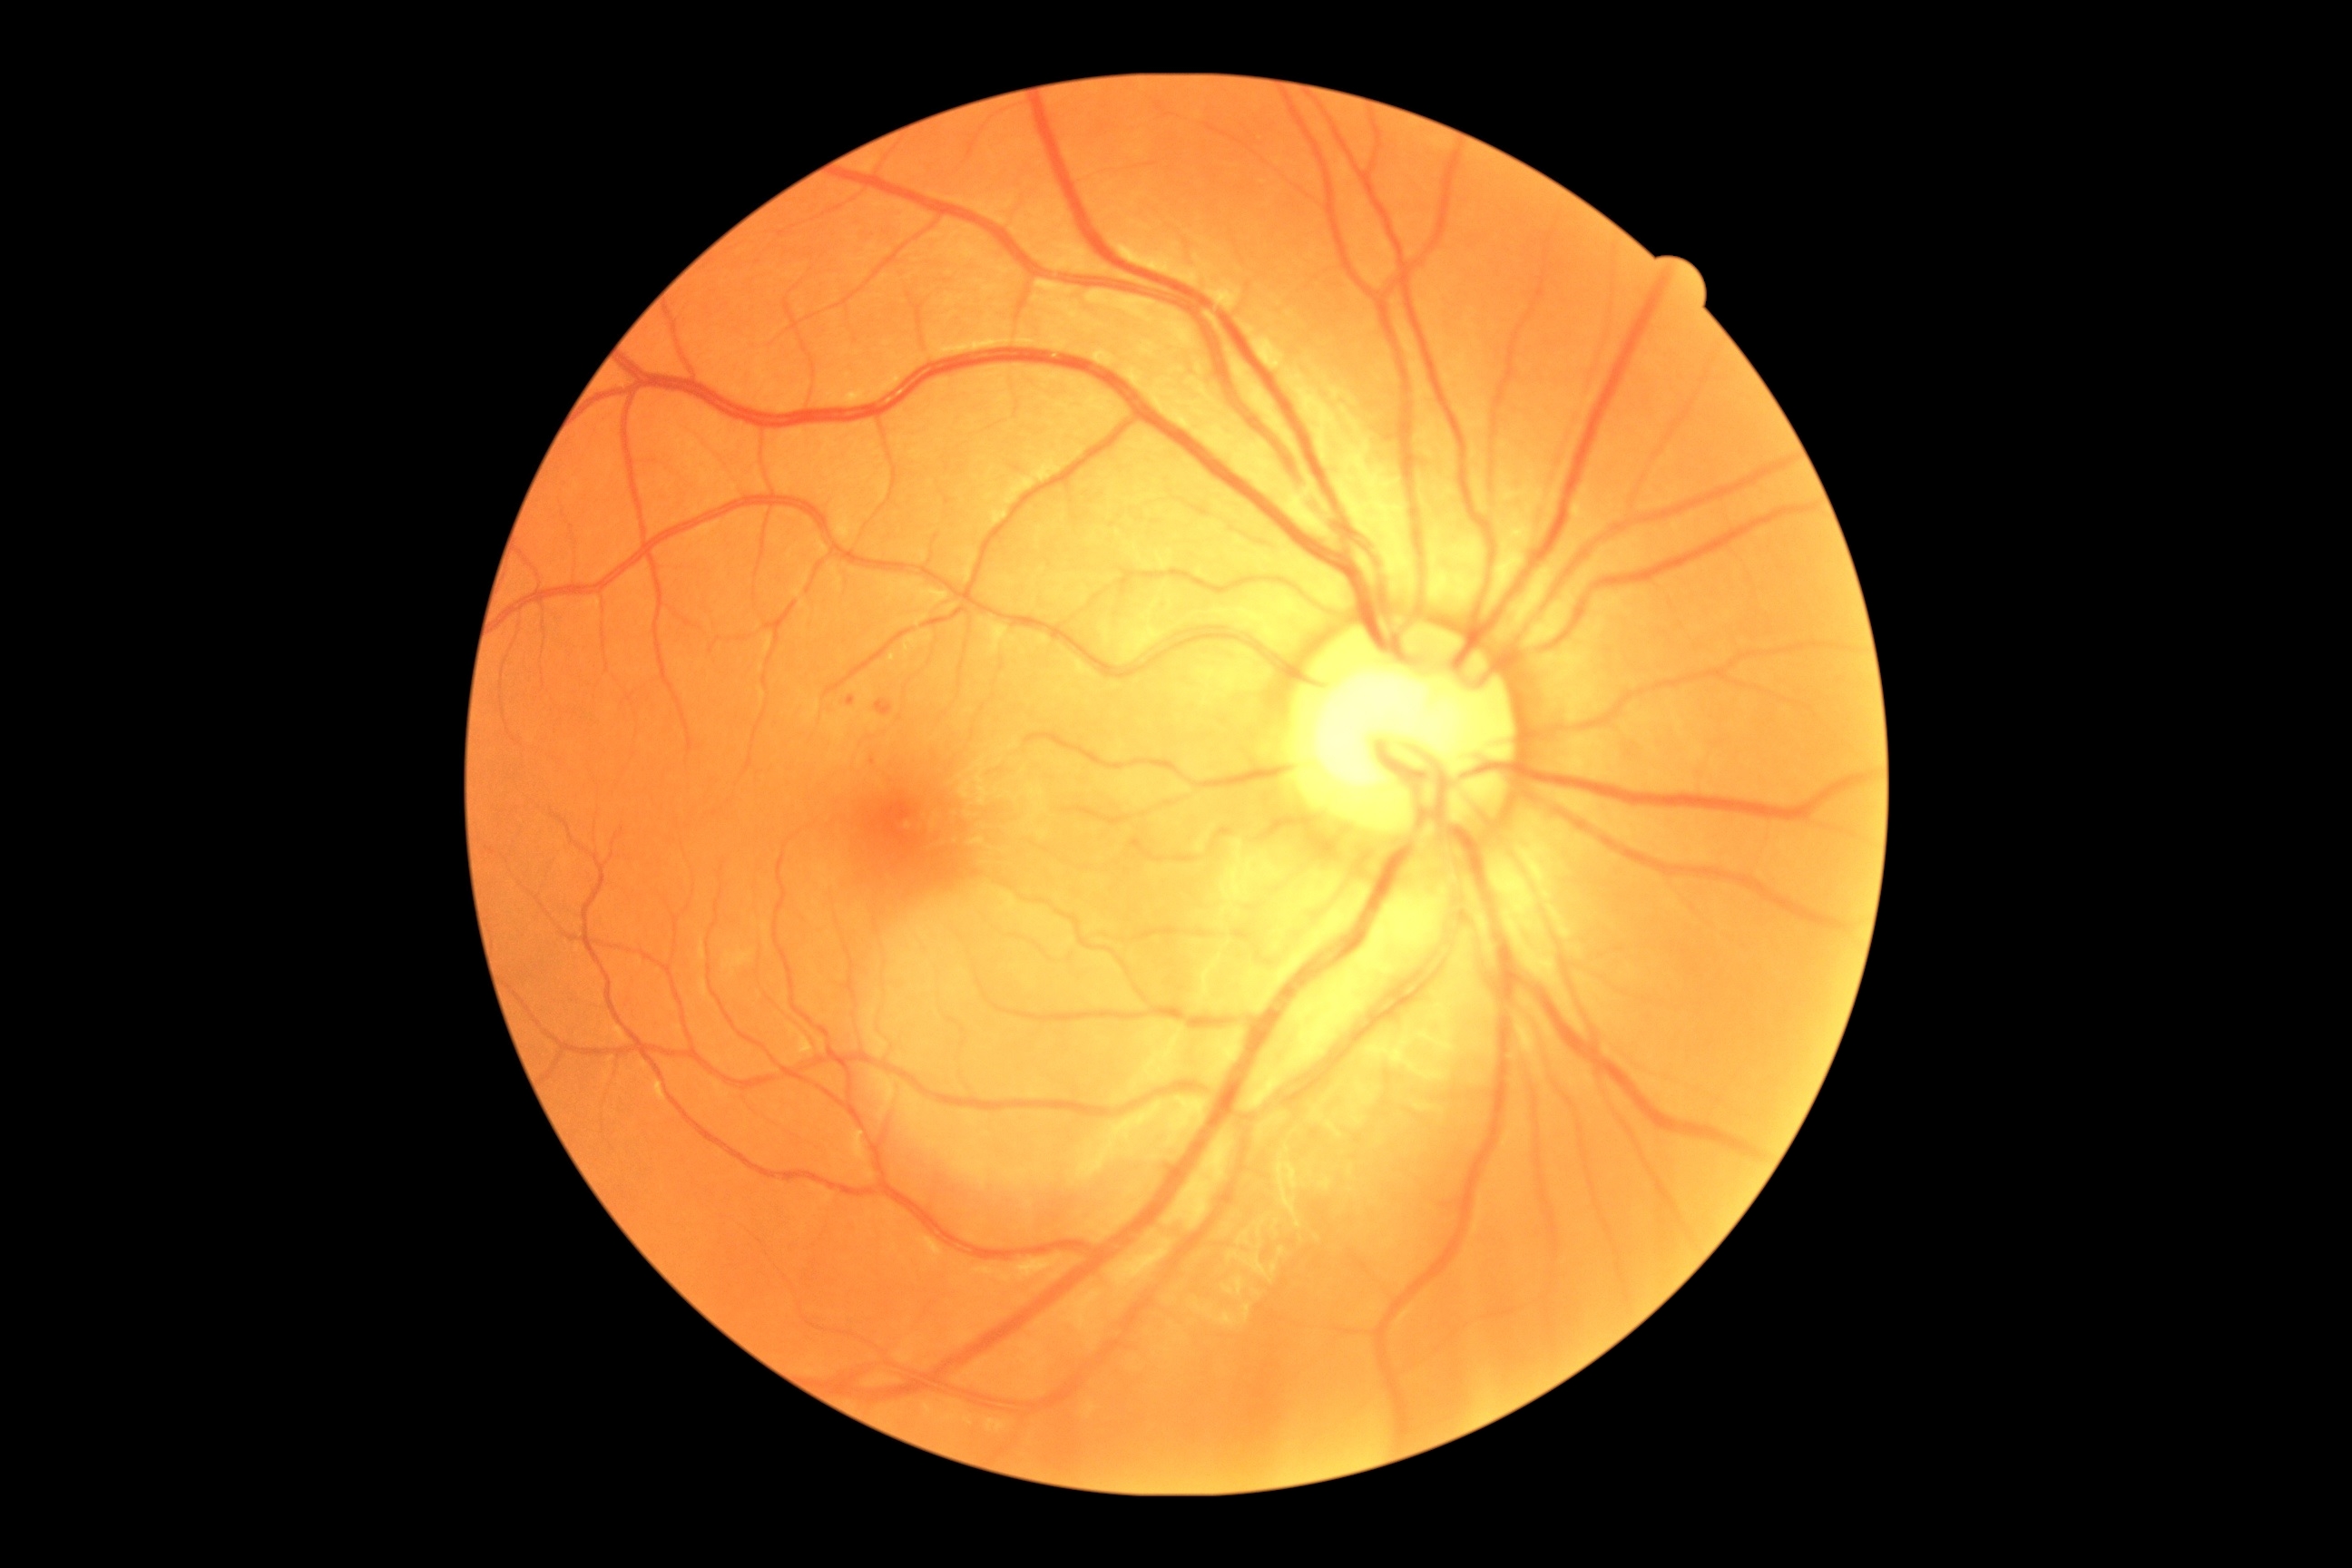

Diabetic retinopathy (DR): 1/4
Findings:
• microaneurysms (MAs): box(876, 700, 894, 718), box(847, 696, 856, 707)
• Smaller MAs around <point>873, 761</point>
• hard exudates (EXs): none detected
• soft exudates (SEs): none detected
• hemorrhages (HEs): none detected